Wide-field fundus photograph from neonatal ROP screening
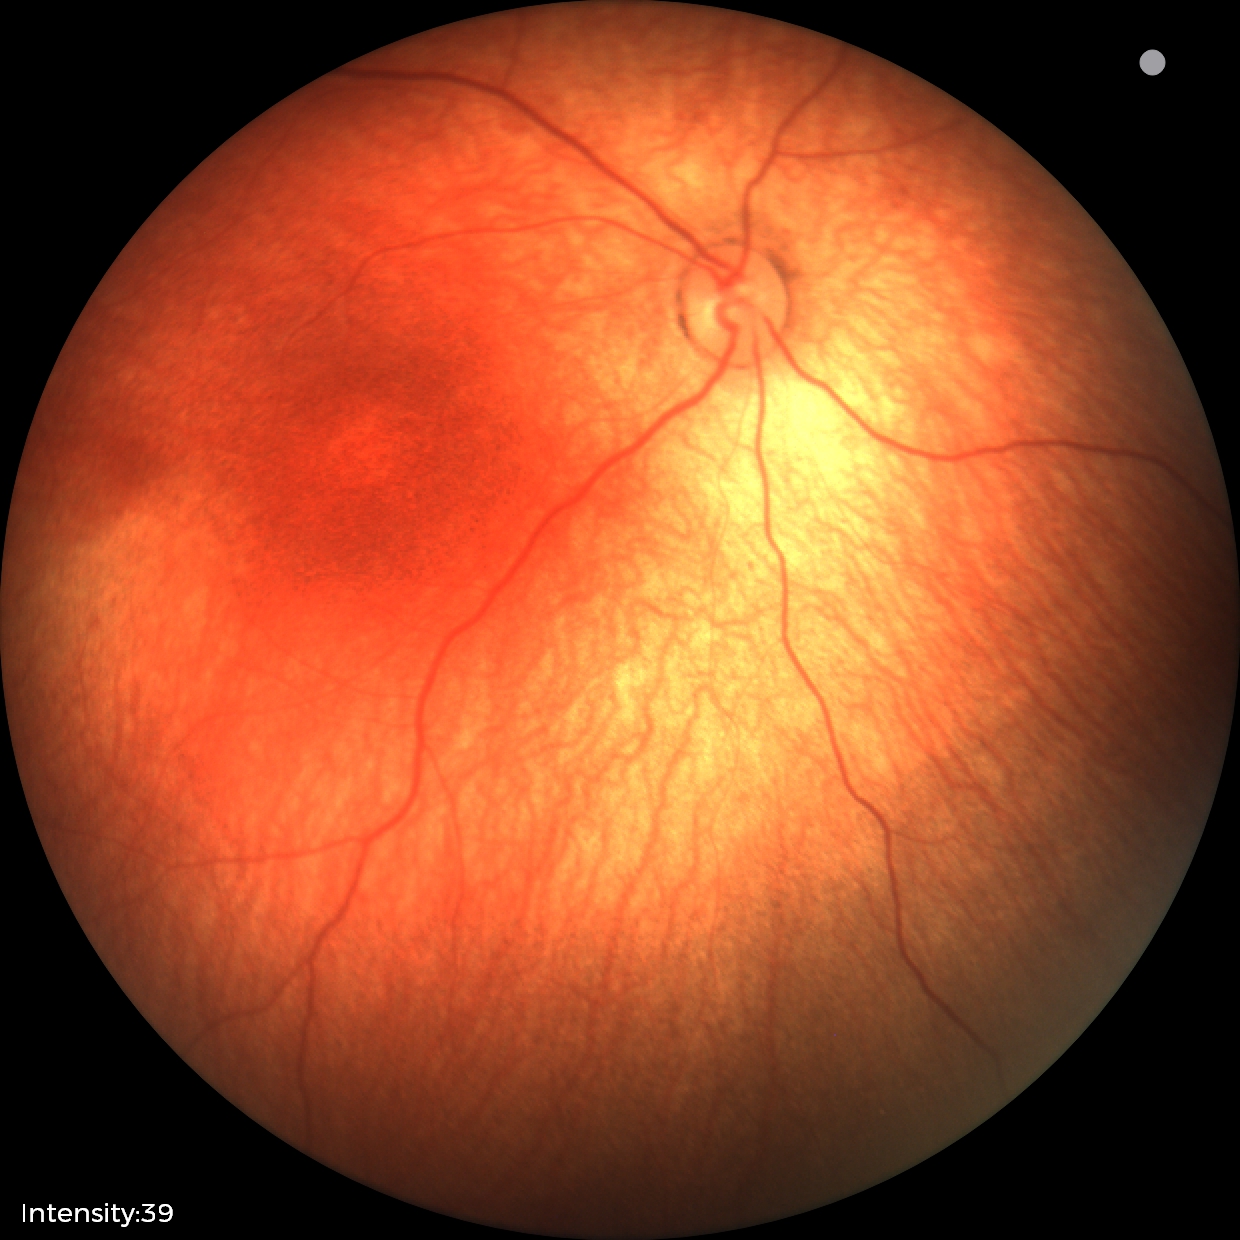

Assessment = no abnormalities.